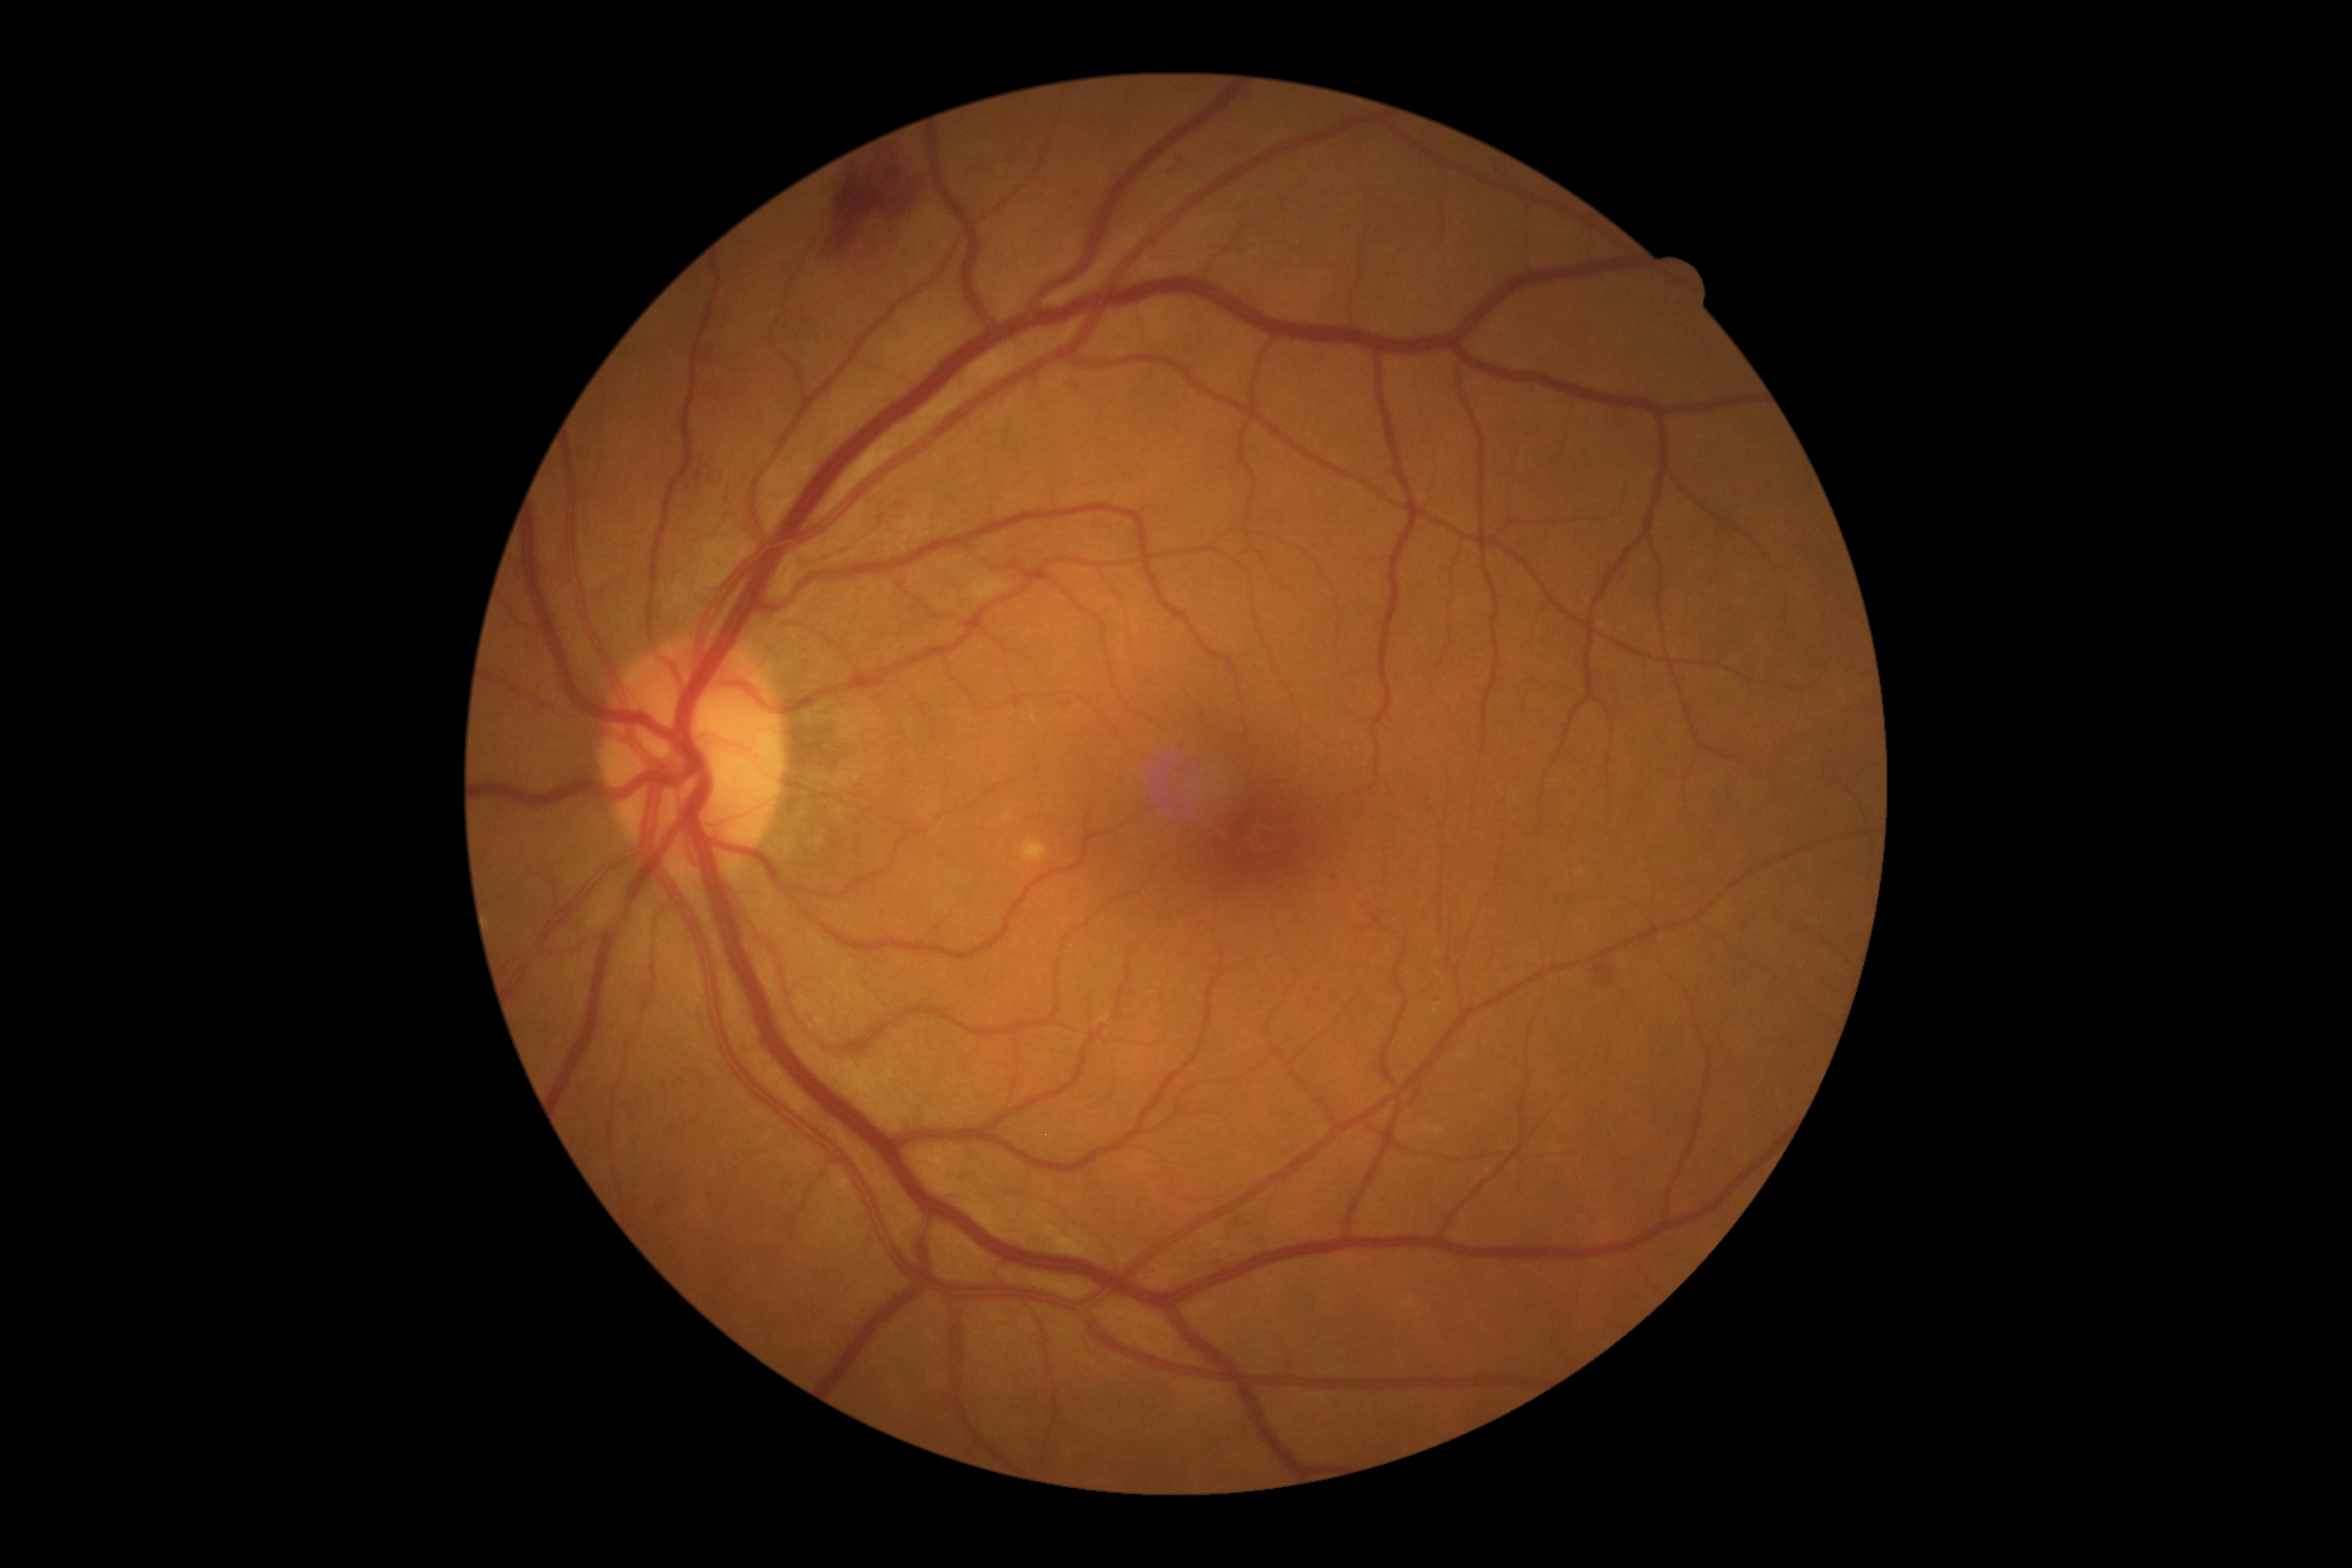

Retinopathy is grade 2 (moderate NPDR). The retinopathy is classified as non-proliferative diabetic retinopathy.